640x480 · infant wide-field fundus photograph · Clarity RetCam 3, 130° FOV: 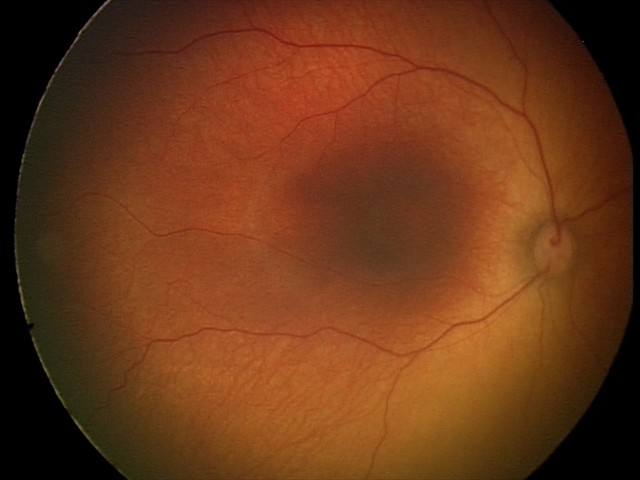 Screening examination diagnosed as physiological.